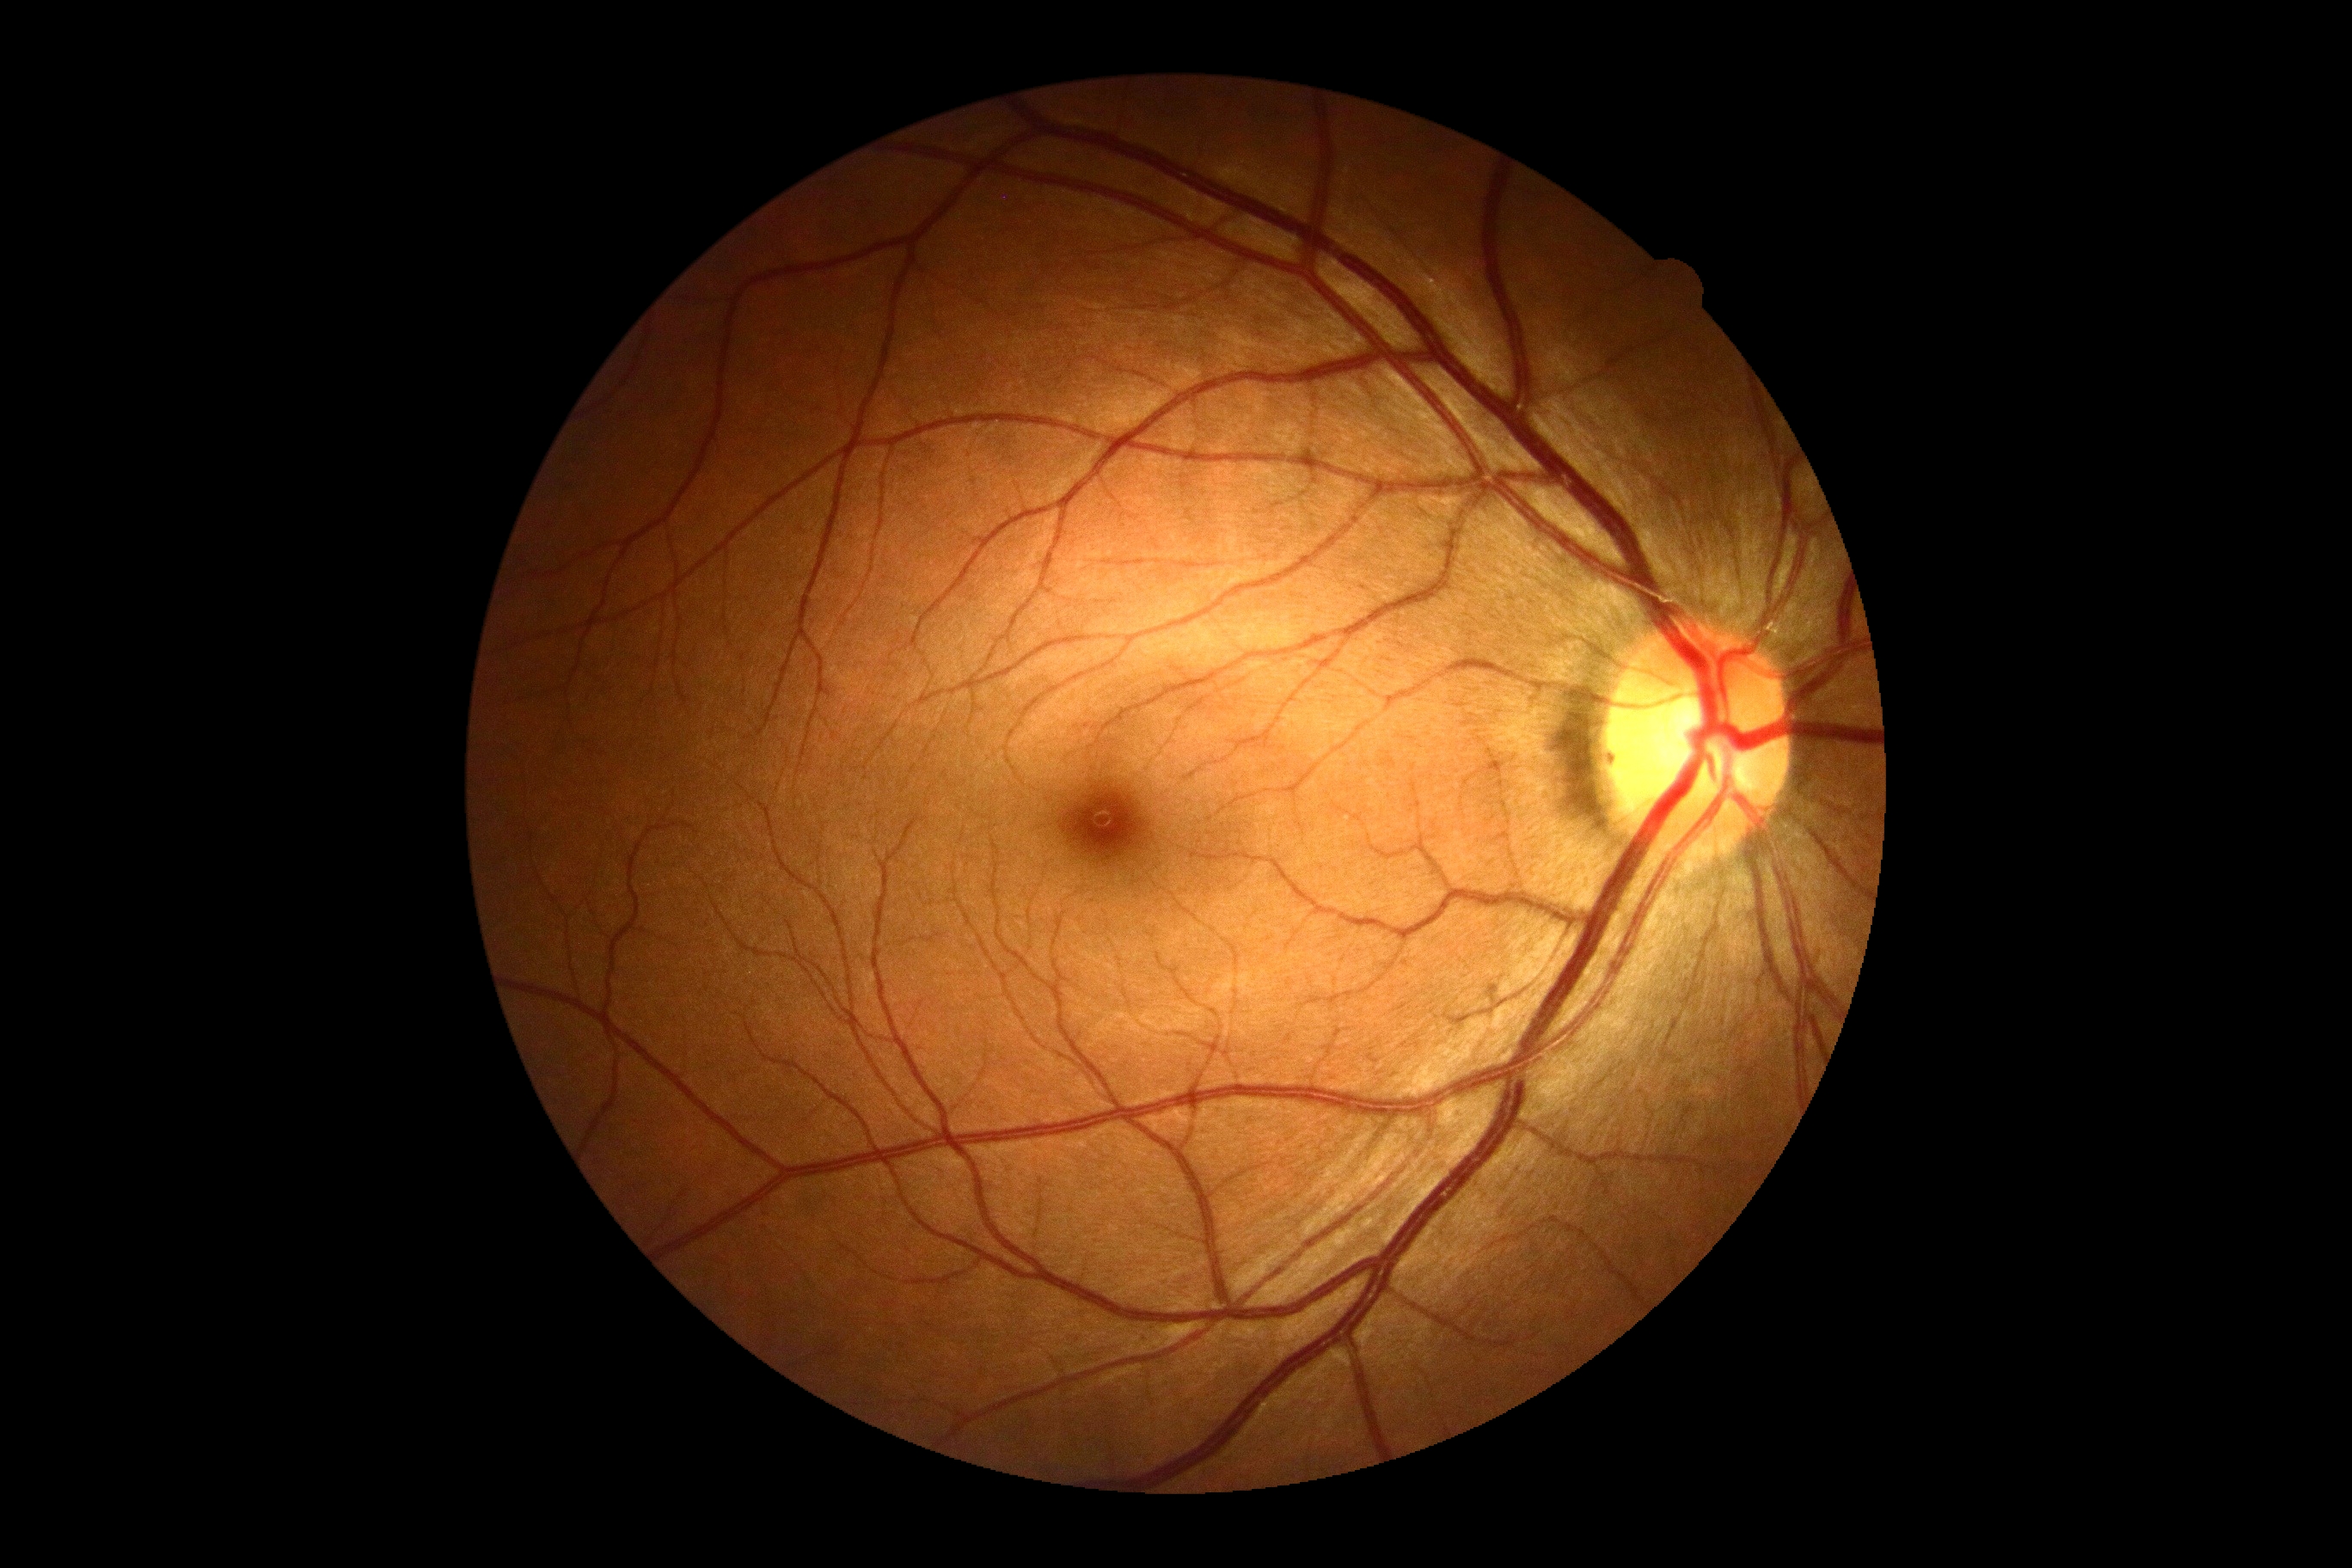

DR severity is grade 0 (no apparent retinopathy).